Wide-field fundus photograph of an infant; 1240x1240px — 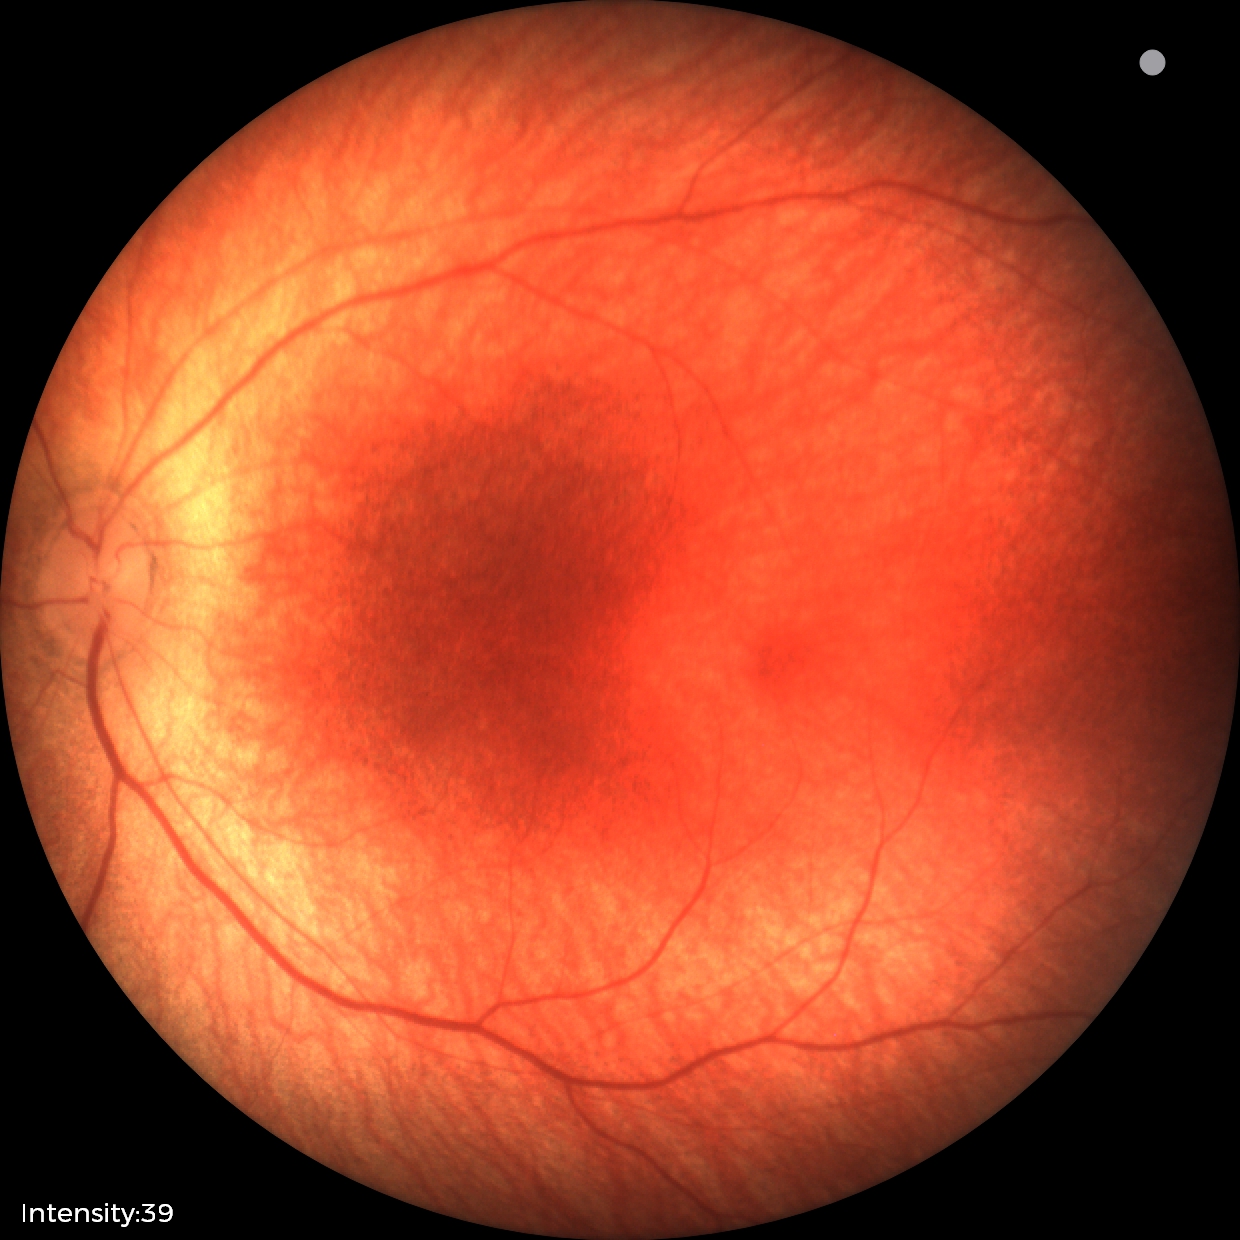 Q: What is the diagnosis from this examination?
A: no abnormal retinal findings